Graded on the modified Davis scale
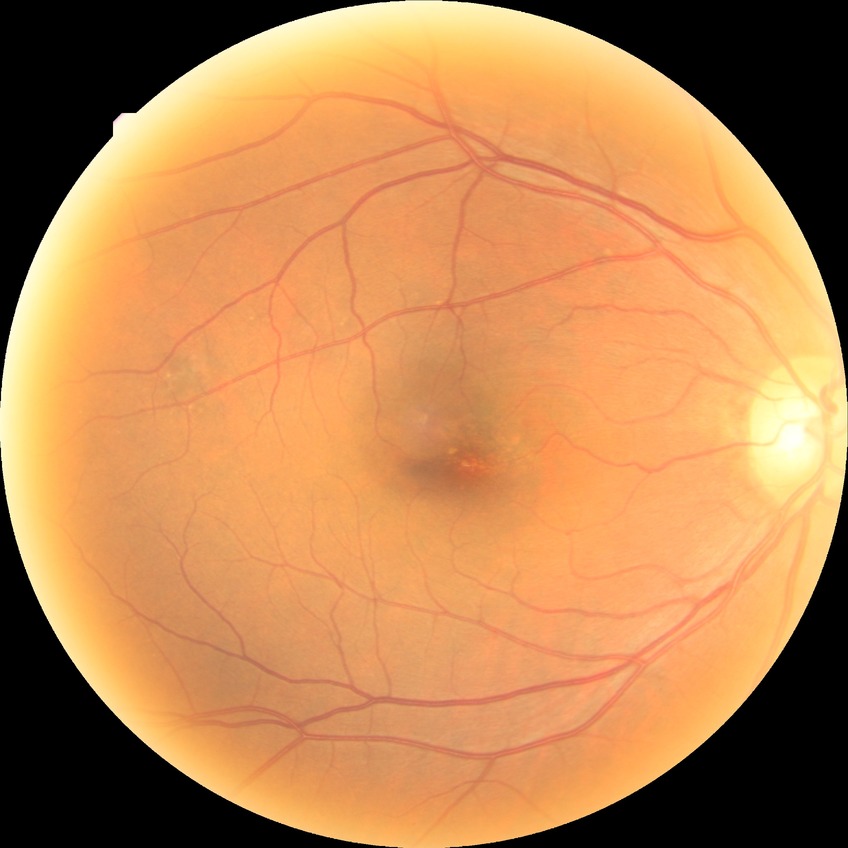

diabetic retinopathy (DR): no diabetic retinopathy (NDR).